848 by 848 pixels · DR severity per modified Davis staging: 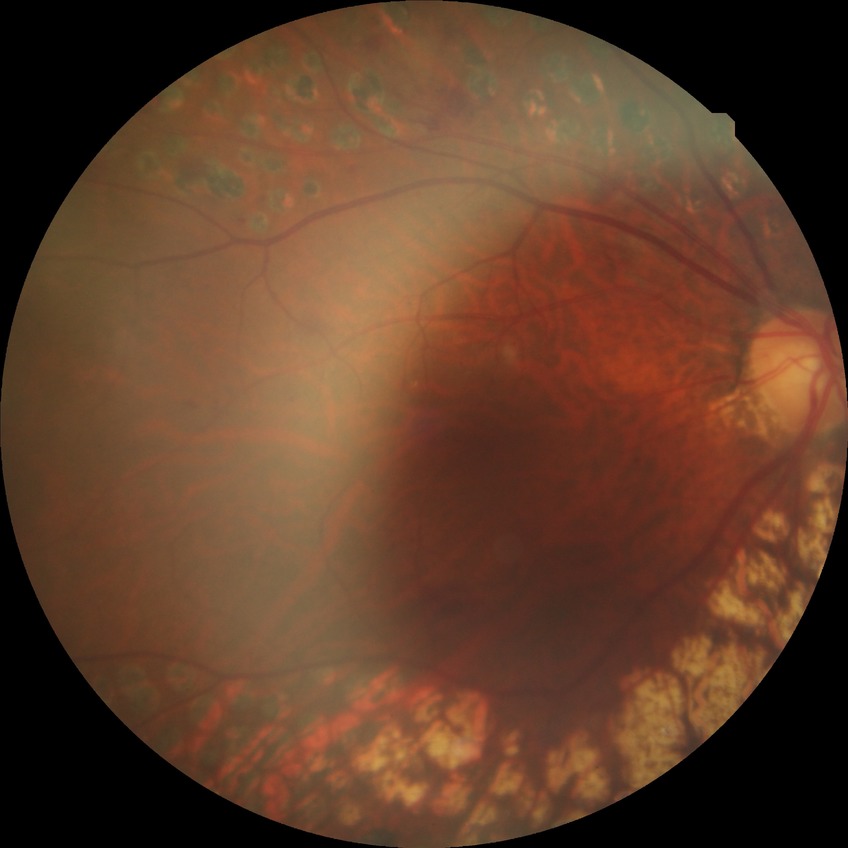
Diabetic retinopathy (DR): PDR (proliferative diabetic retinopathy).